NIDEK AFC-230, graded on the modified Davis scale
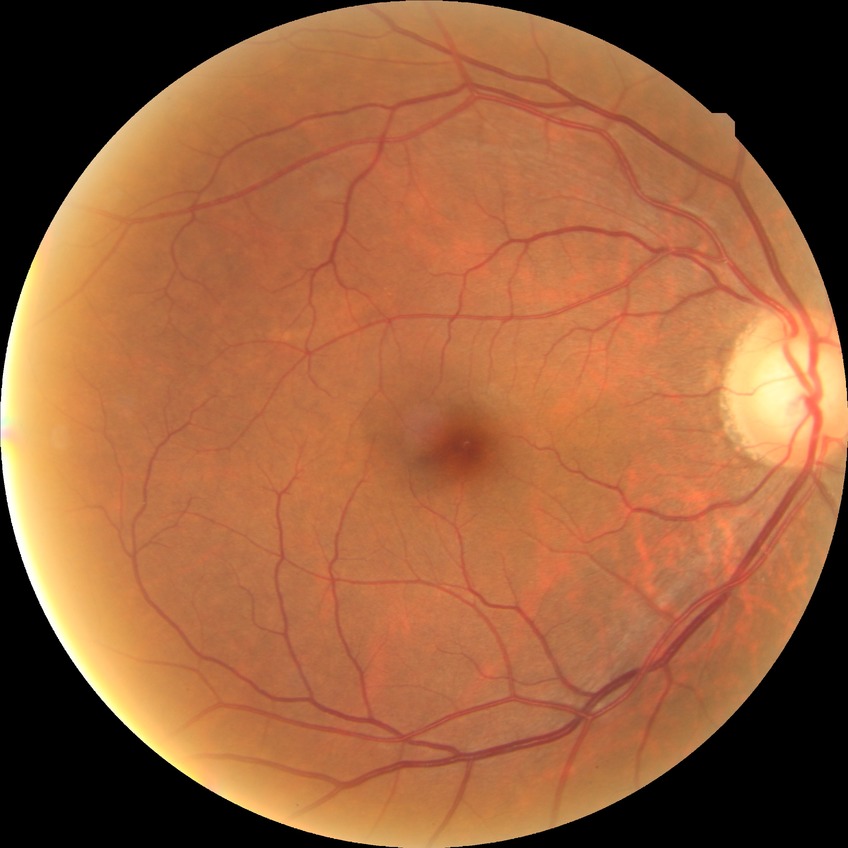

modified Davis classification=no diabetic retinopathy.